FOV: 45 degrees, CFP:
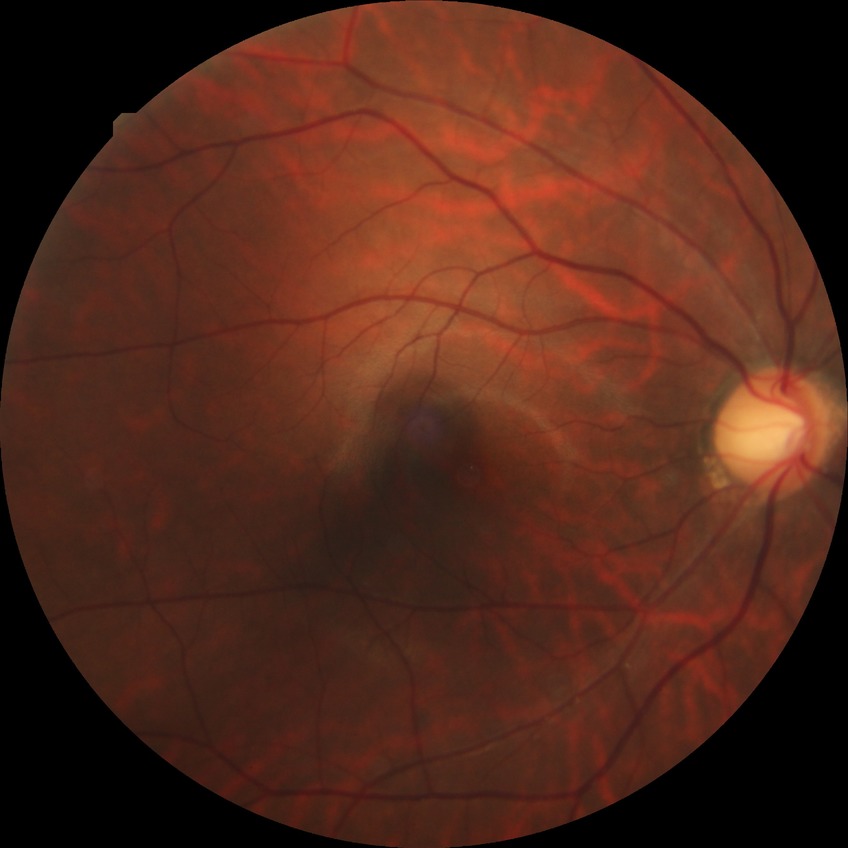

Davis grading is no diabetic retinopathy.